Modified Davis grading.
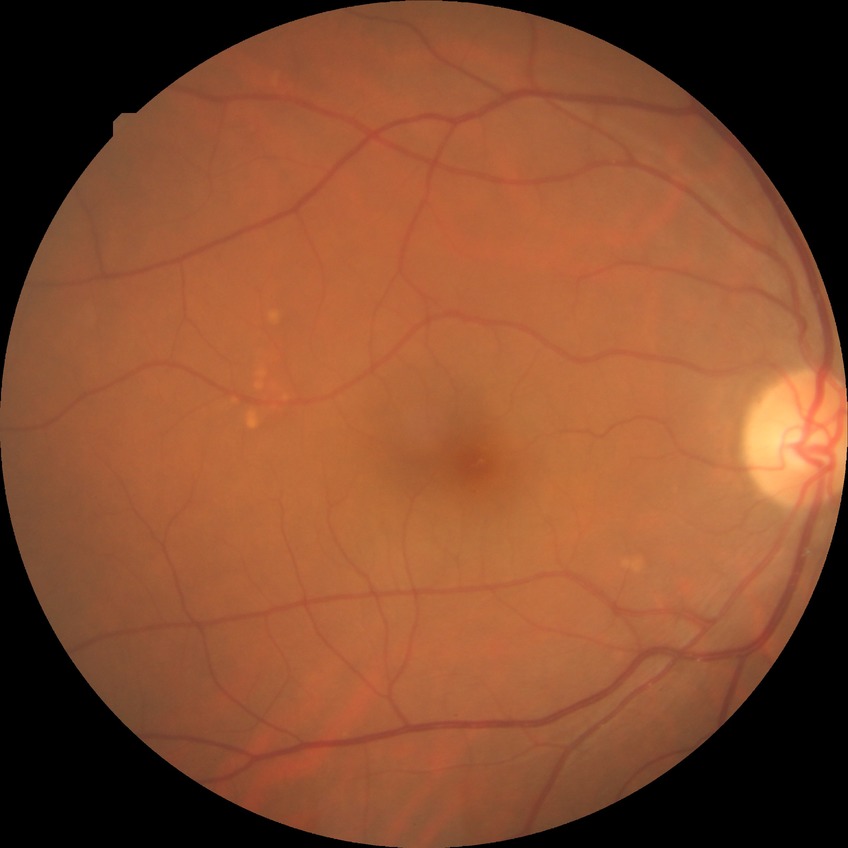

  davis_grade: no diabetic retinopathy